Pediatric wide-field fundus photograph
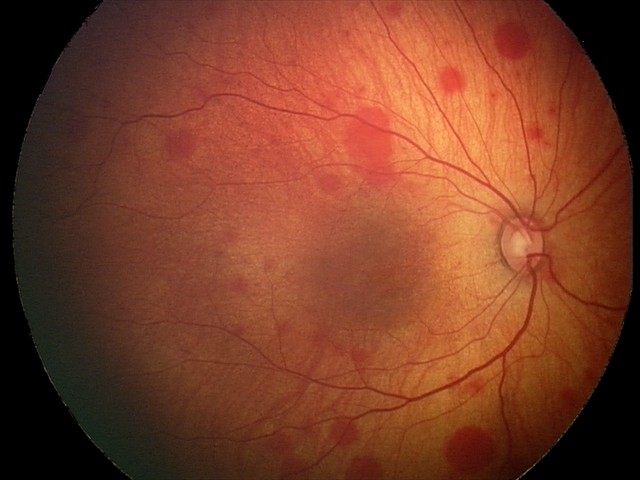
Screening examination consistent with retinal hemorrhages.